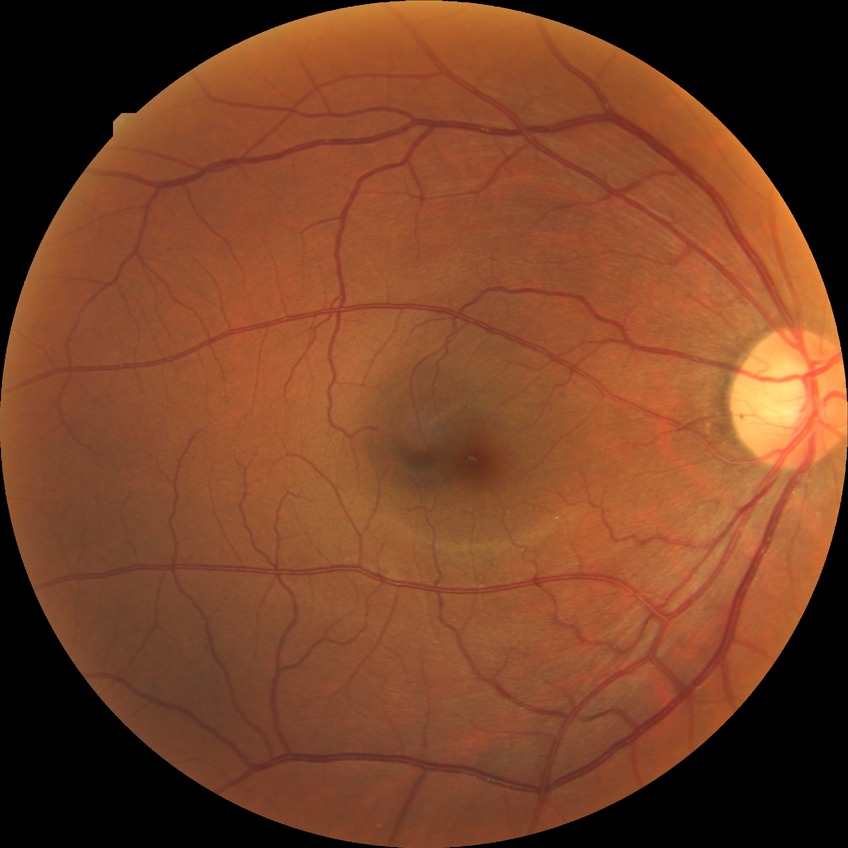

davis_grade: NDR